Davis DR grading. Camera: NIDEK AFC-230.
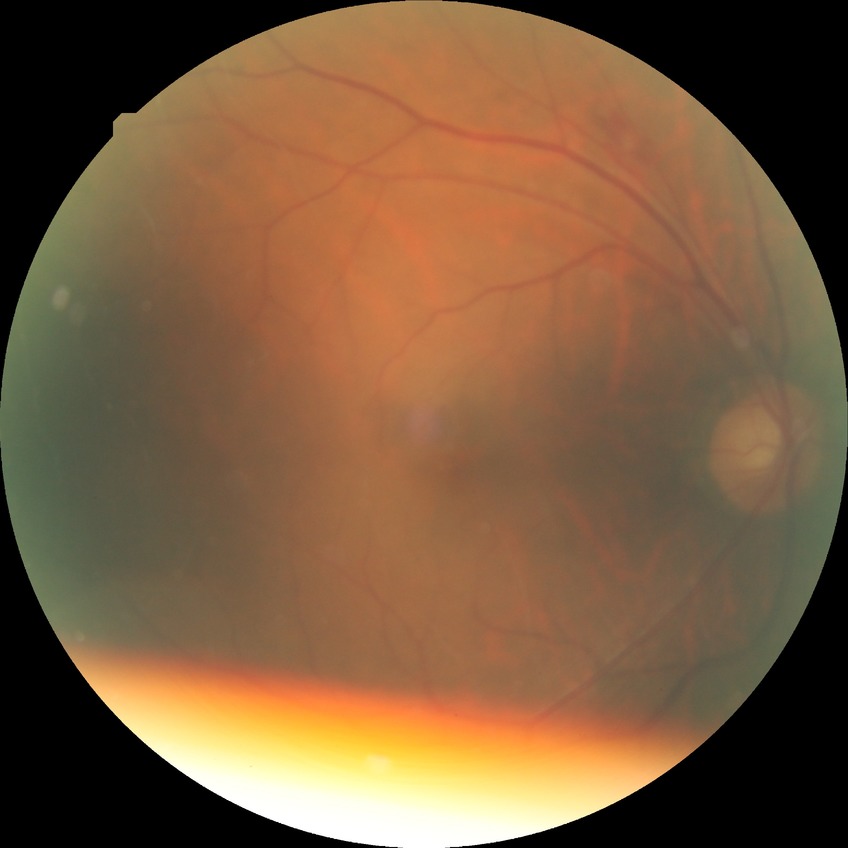
Findings:
– Davis grade: SDR